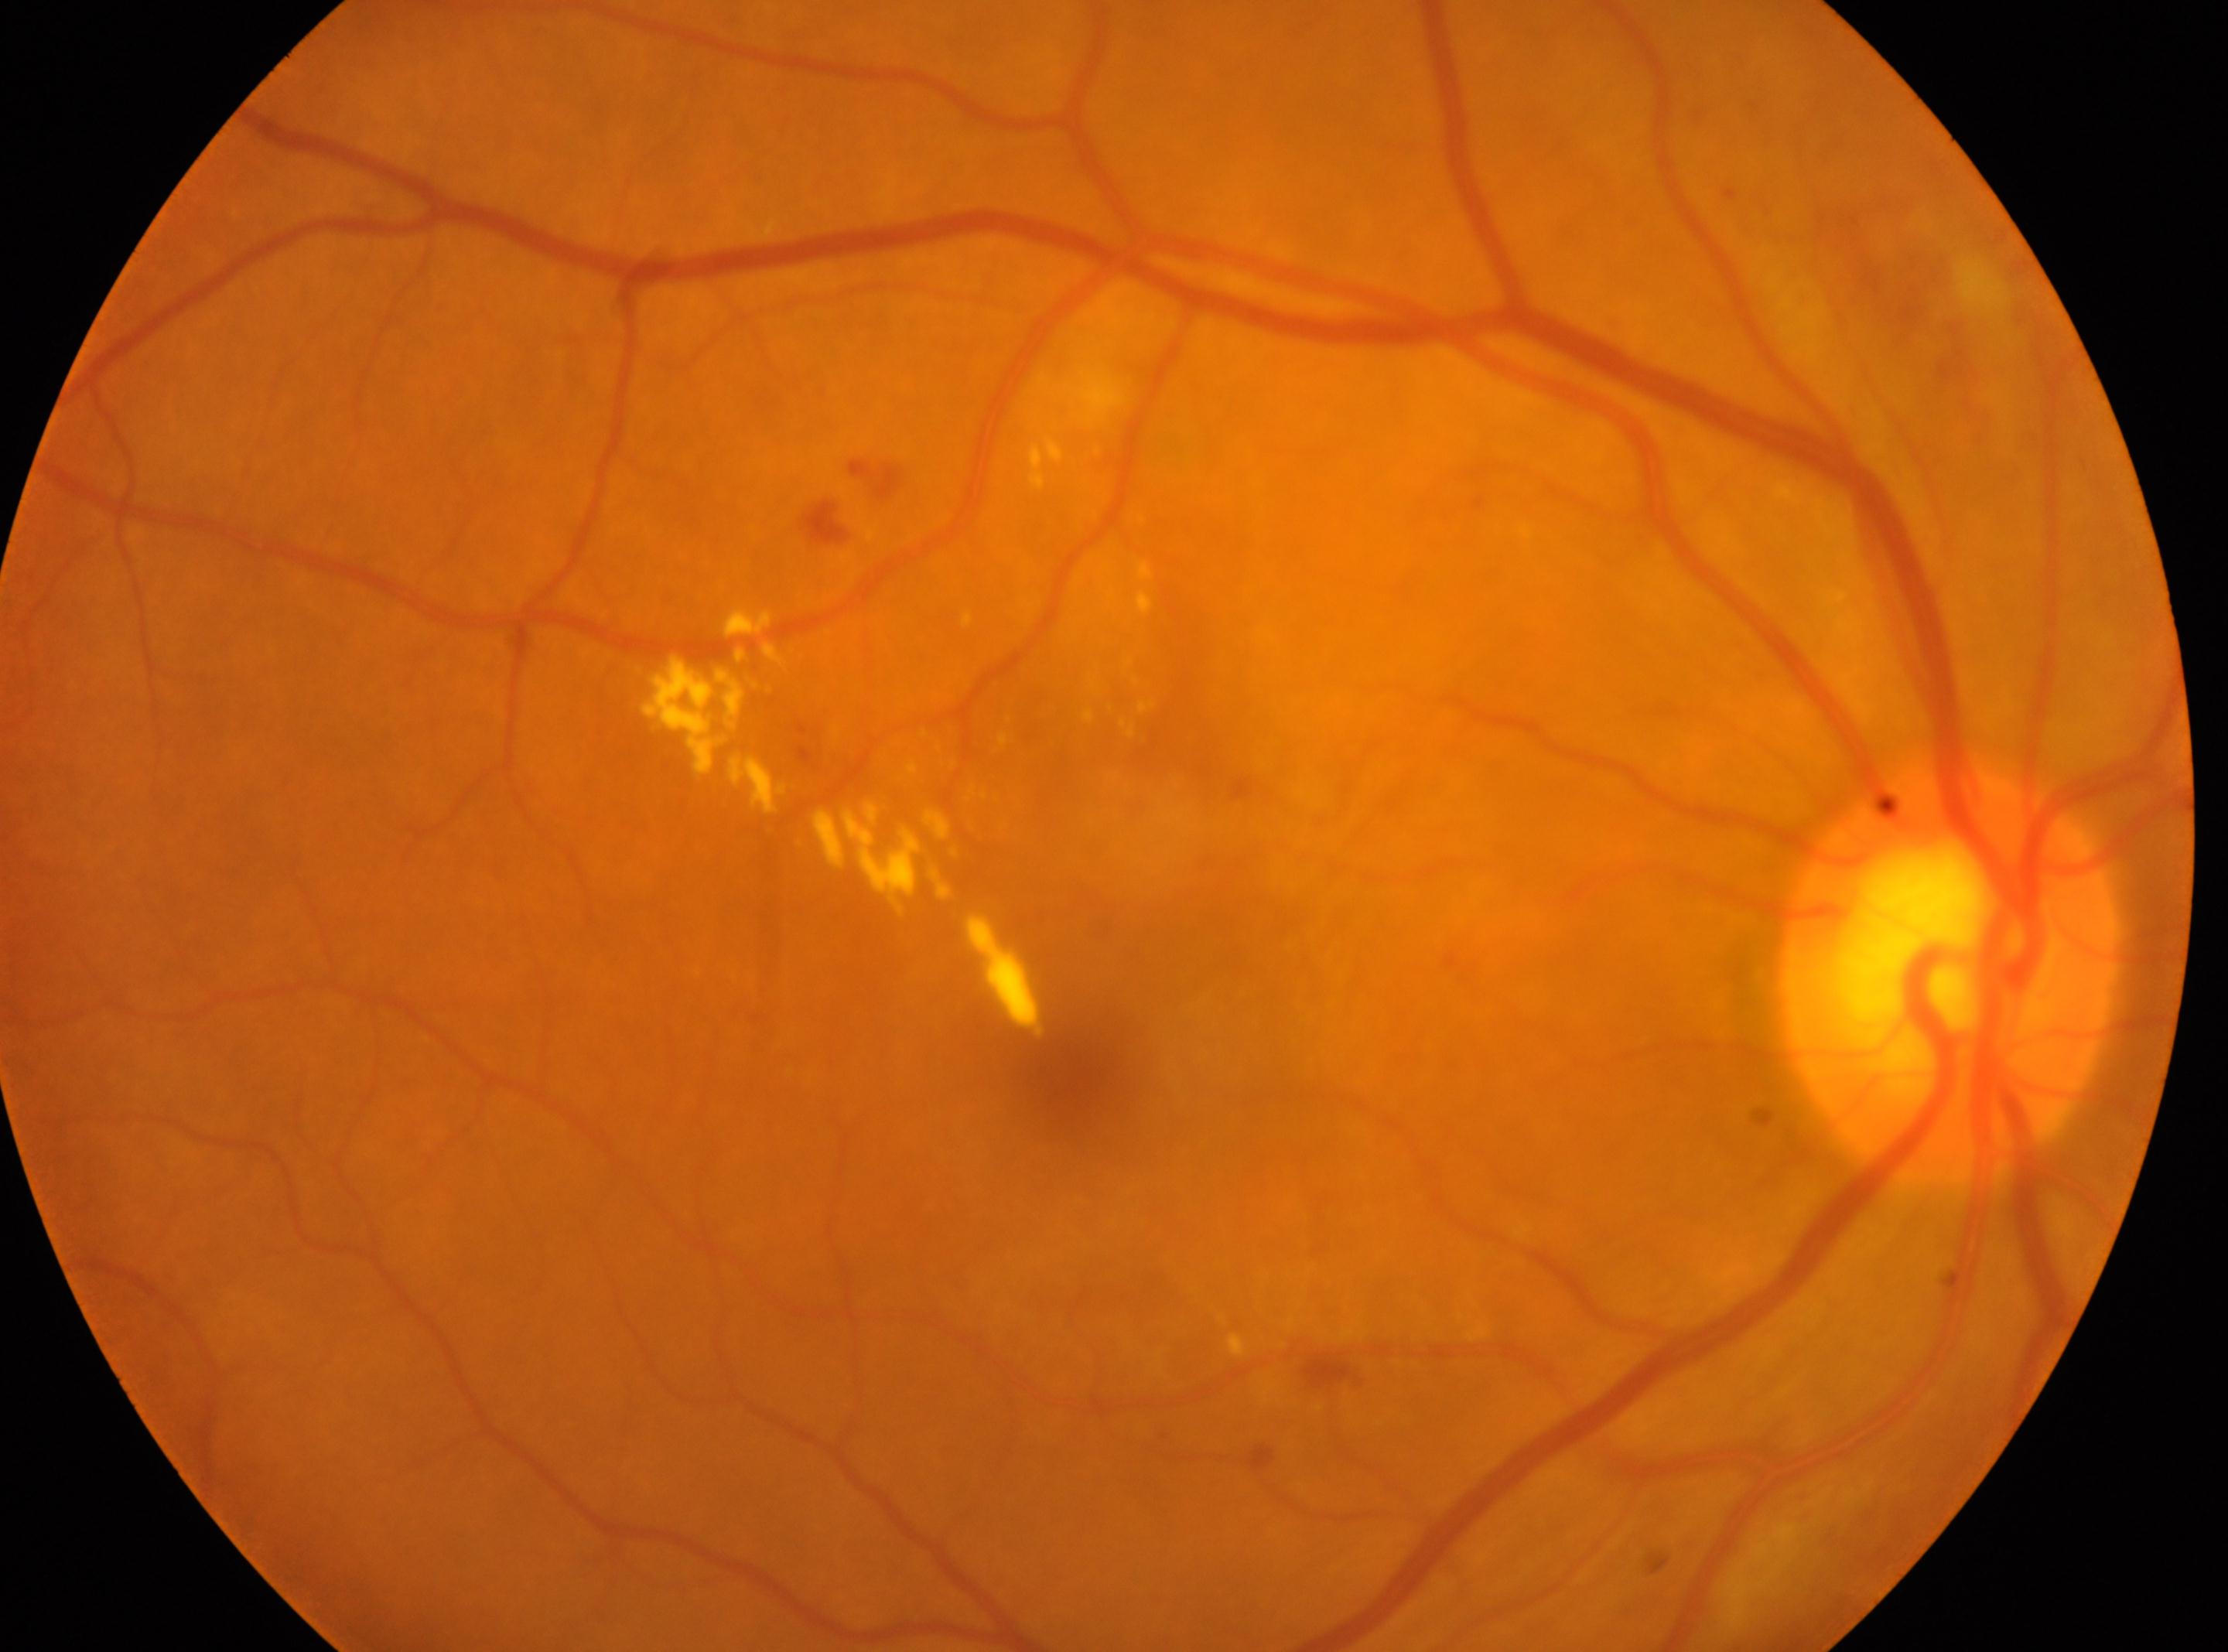
optic nerve head: (x: 1946, y: 973) | DR stage: grade 2 (moderate NPDR) | the right eye | fovea centralis: (x: 1064, y: 1080) | non-proliferative diabetic retinopathy.